Infant wide-field fundus photograph; 1240 by 1240 pixels; Phoenix ICON, 100° FOV: 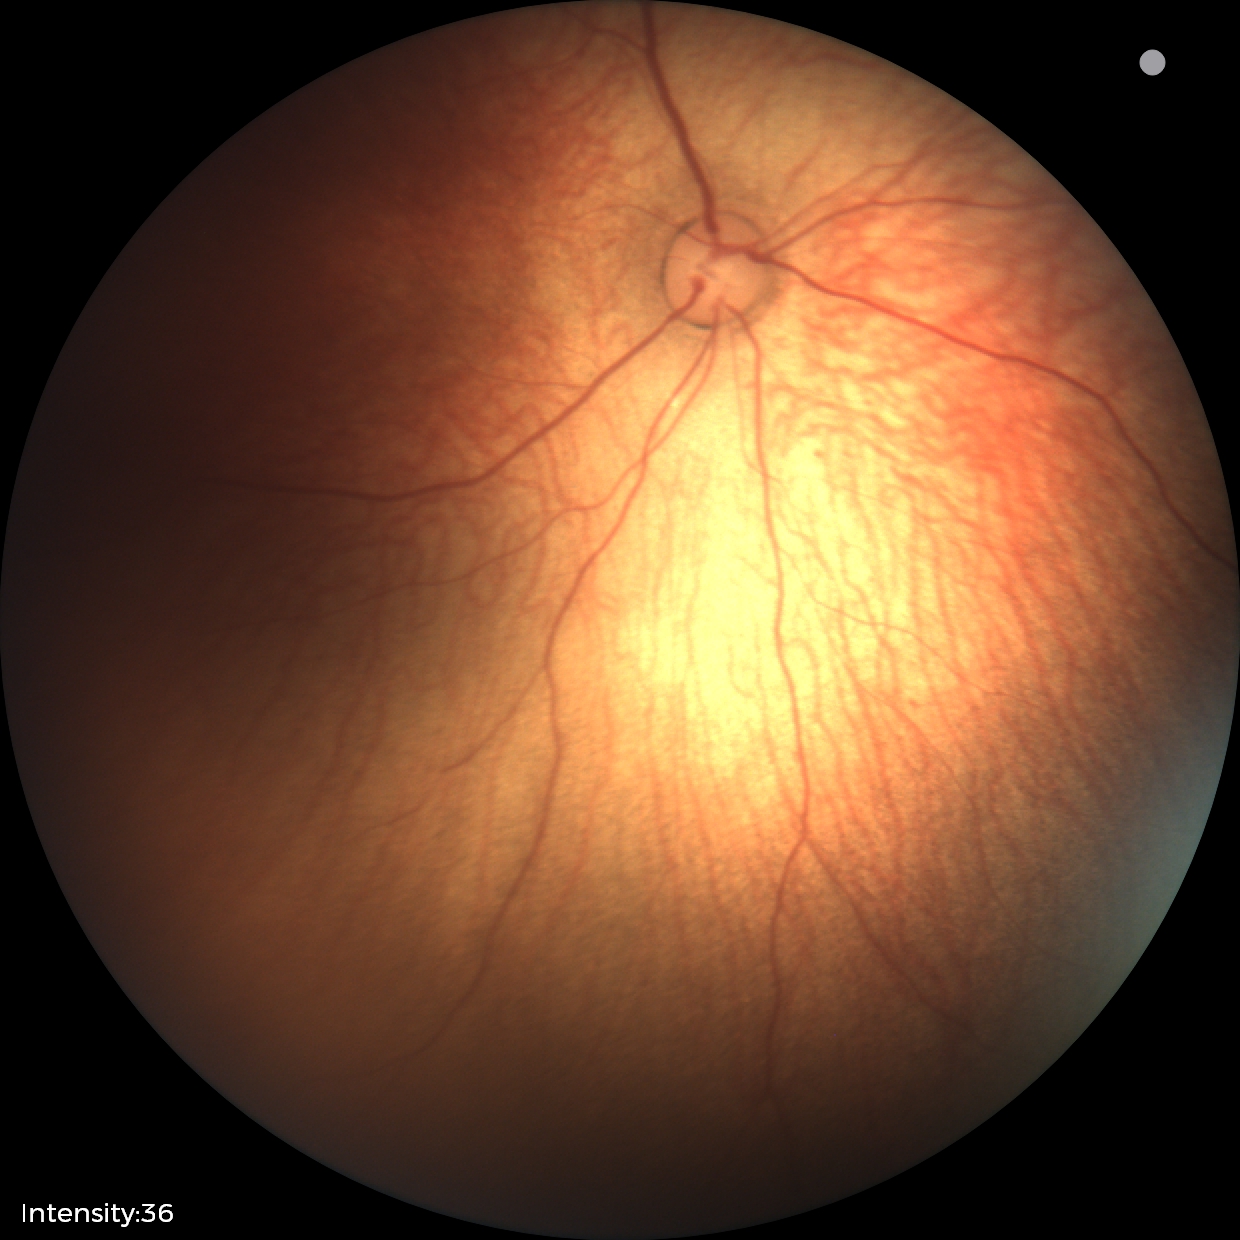
Examination with physiological retinal findings.